45° FOV:
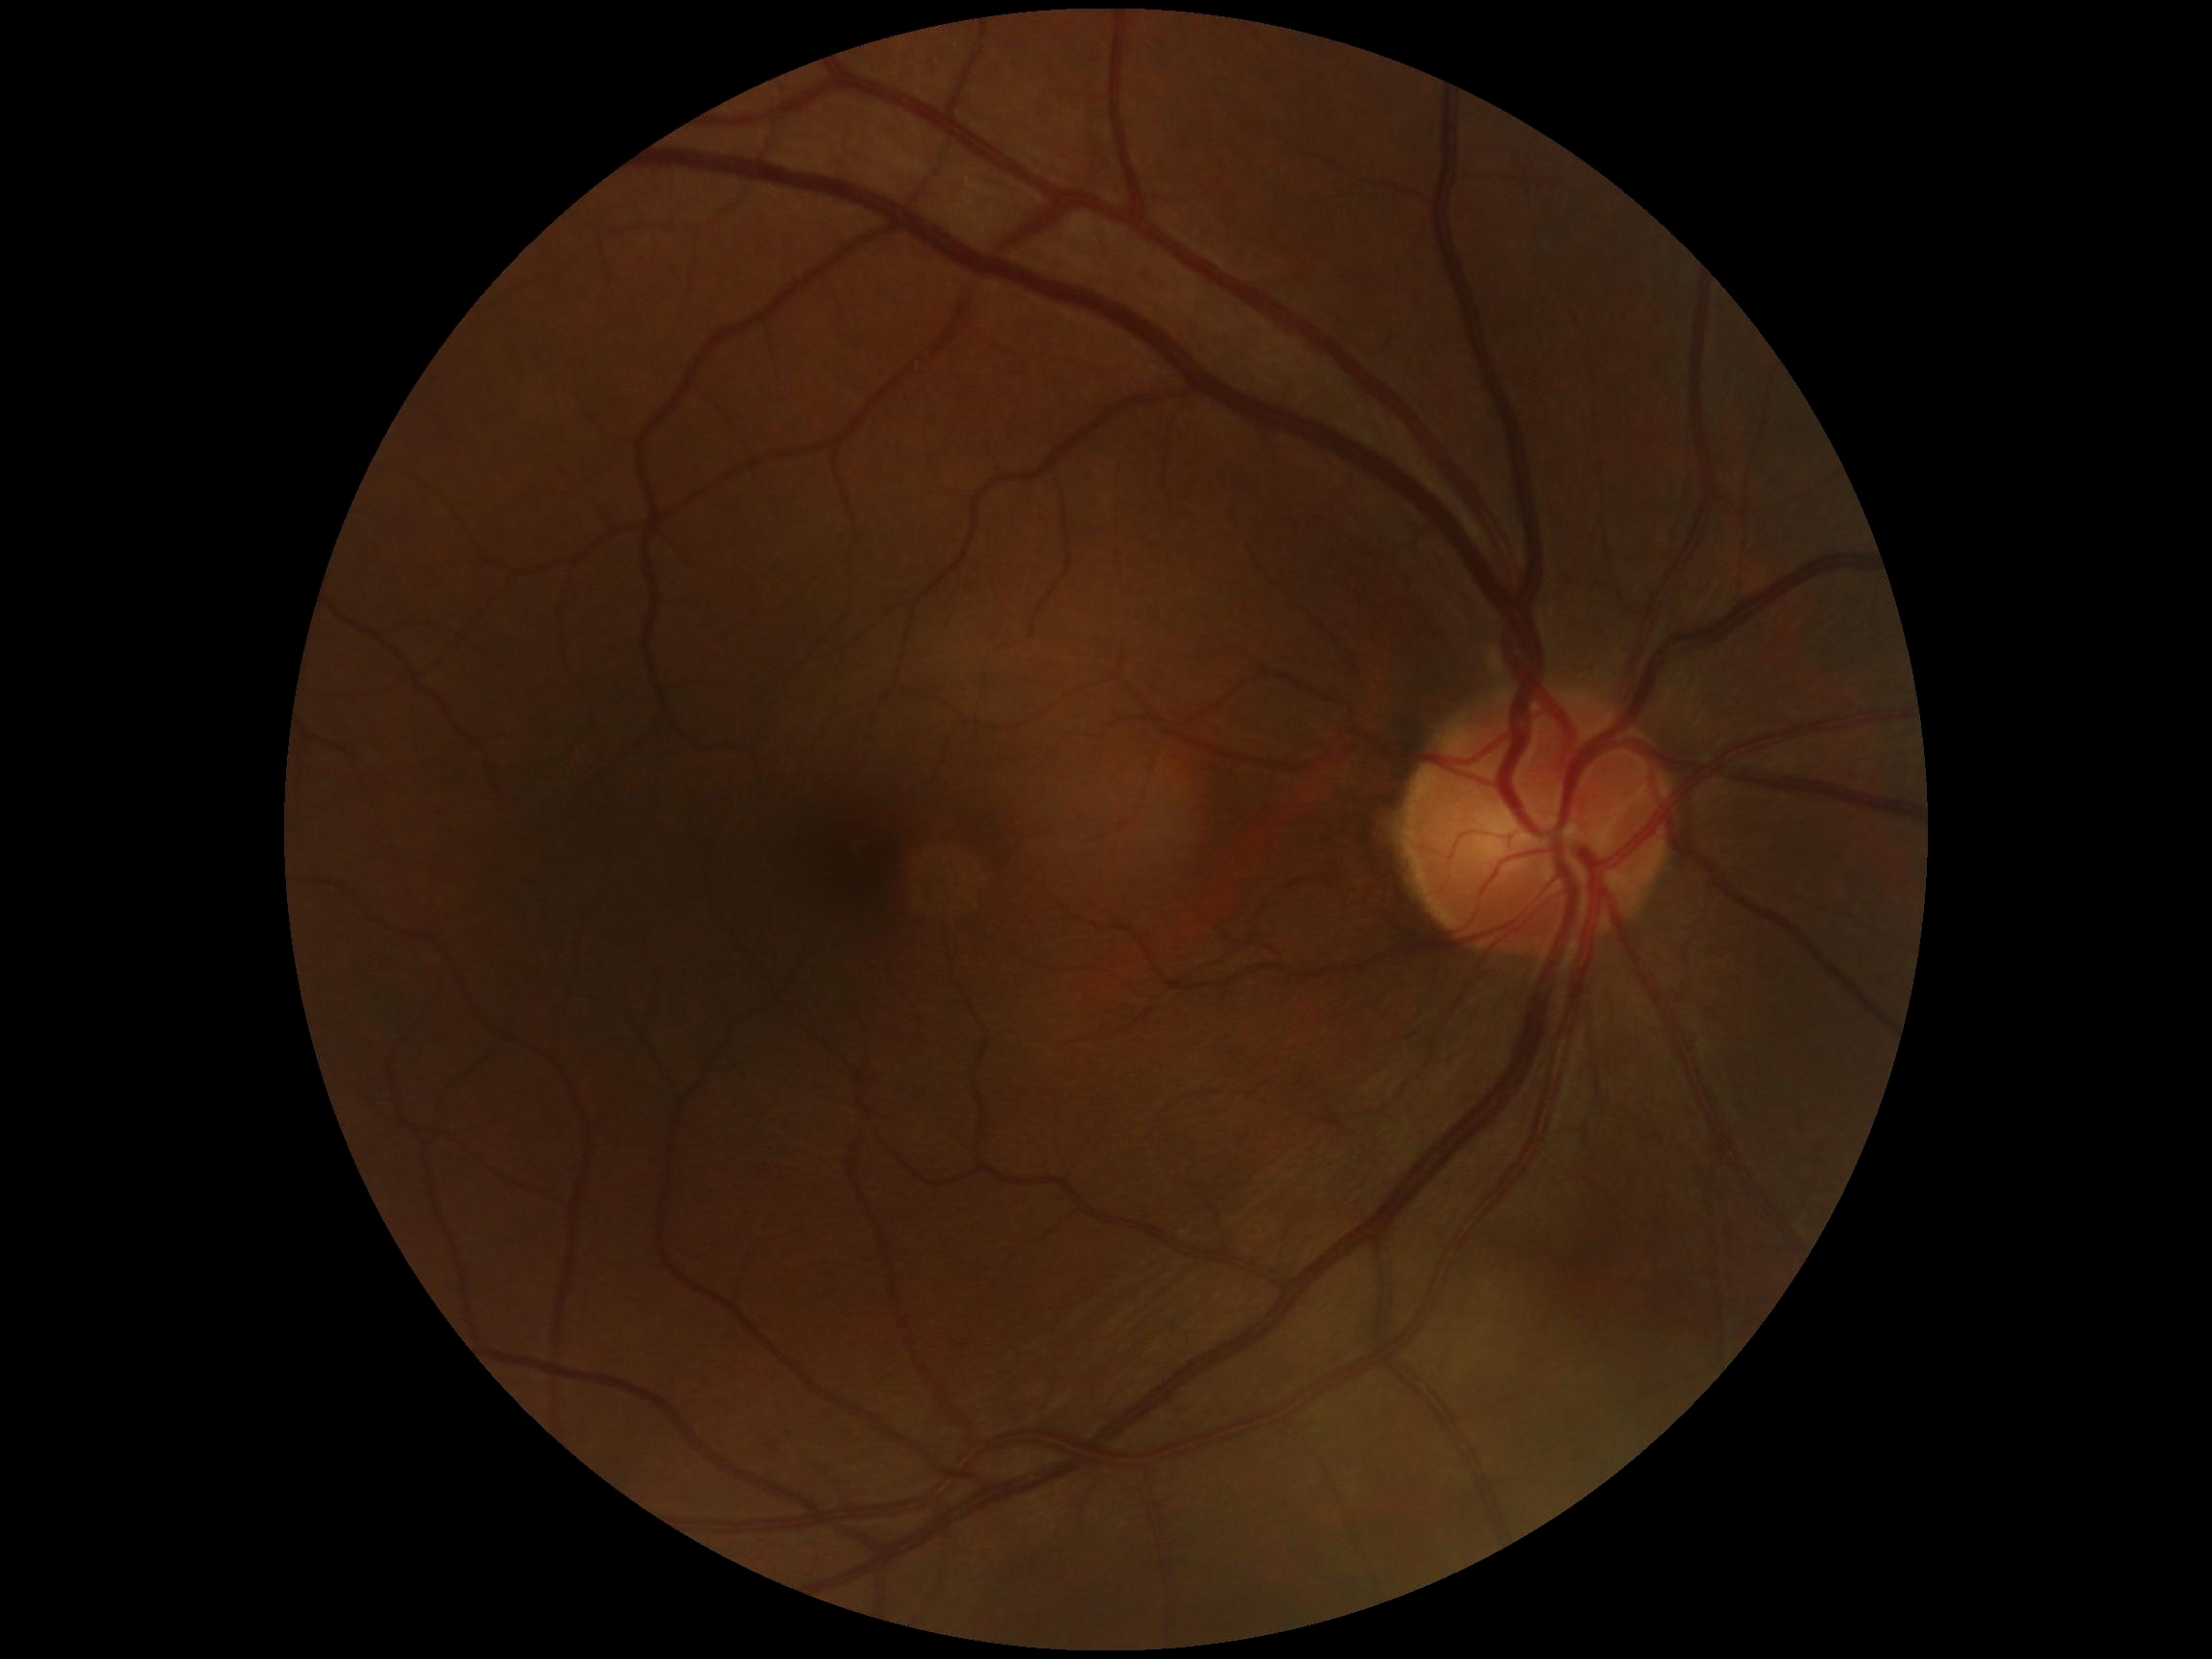 DR grade: 0/4.